Infant wide-field retinal image: 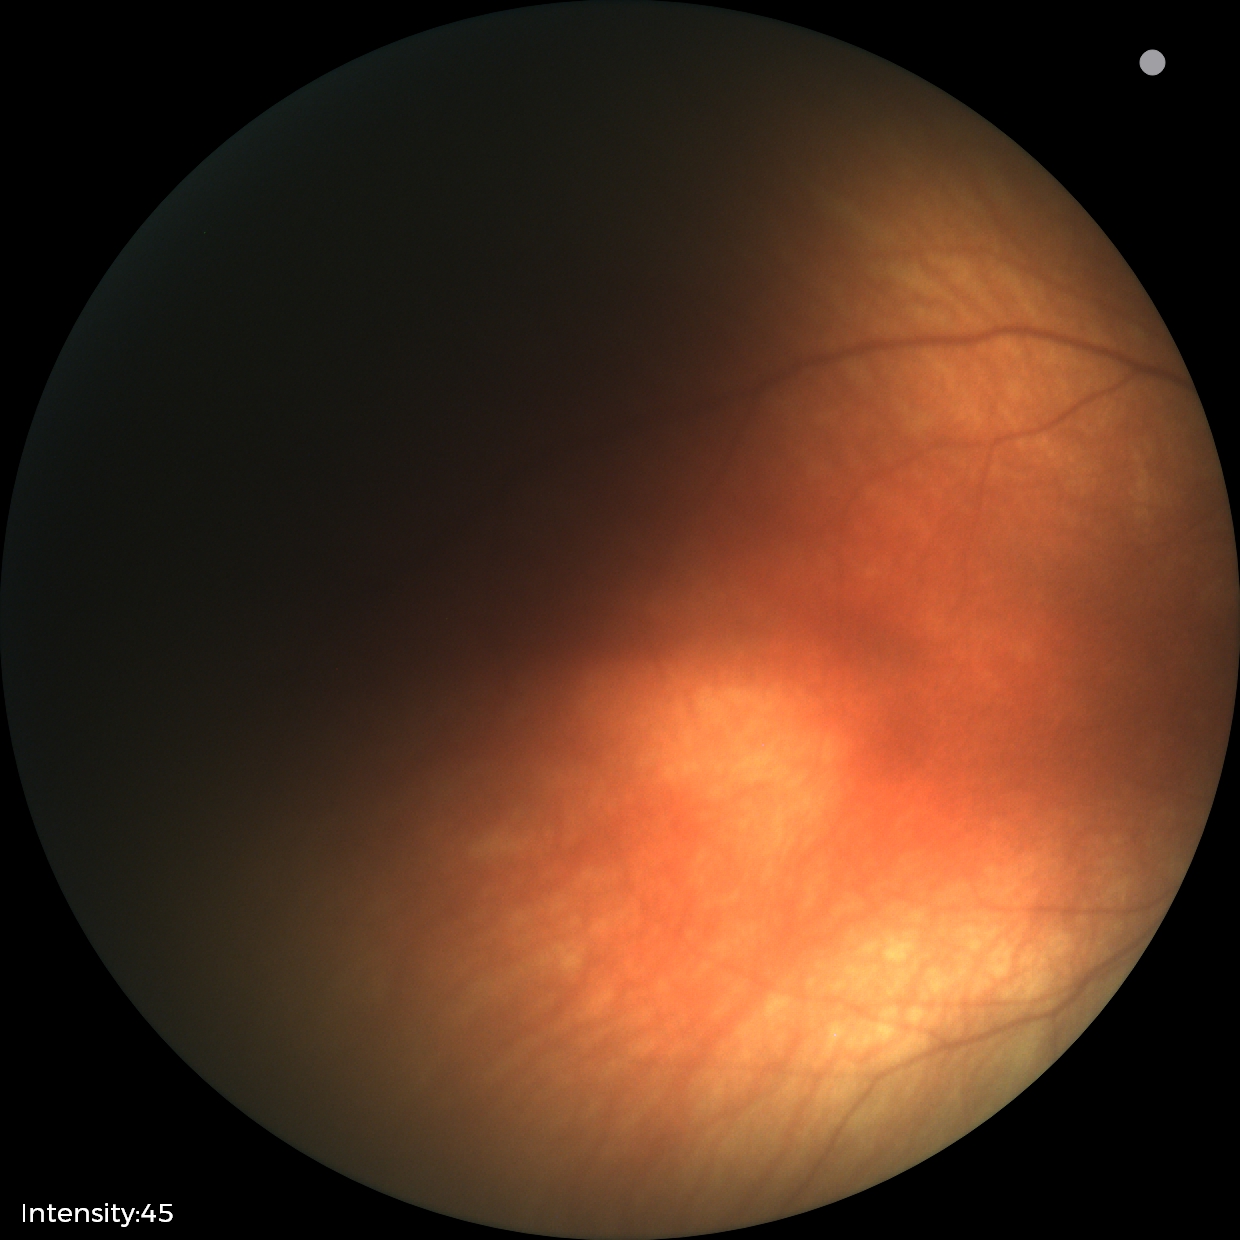

Screening examination with no abnormal retinal findings.